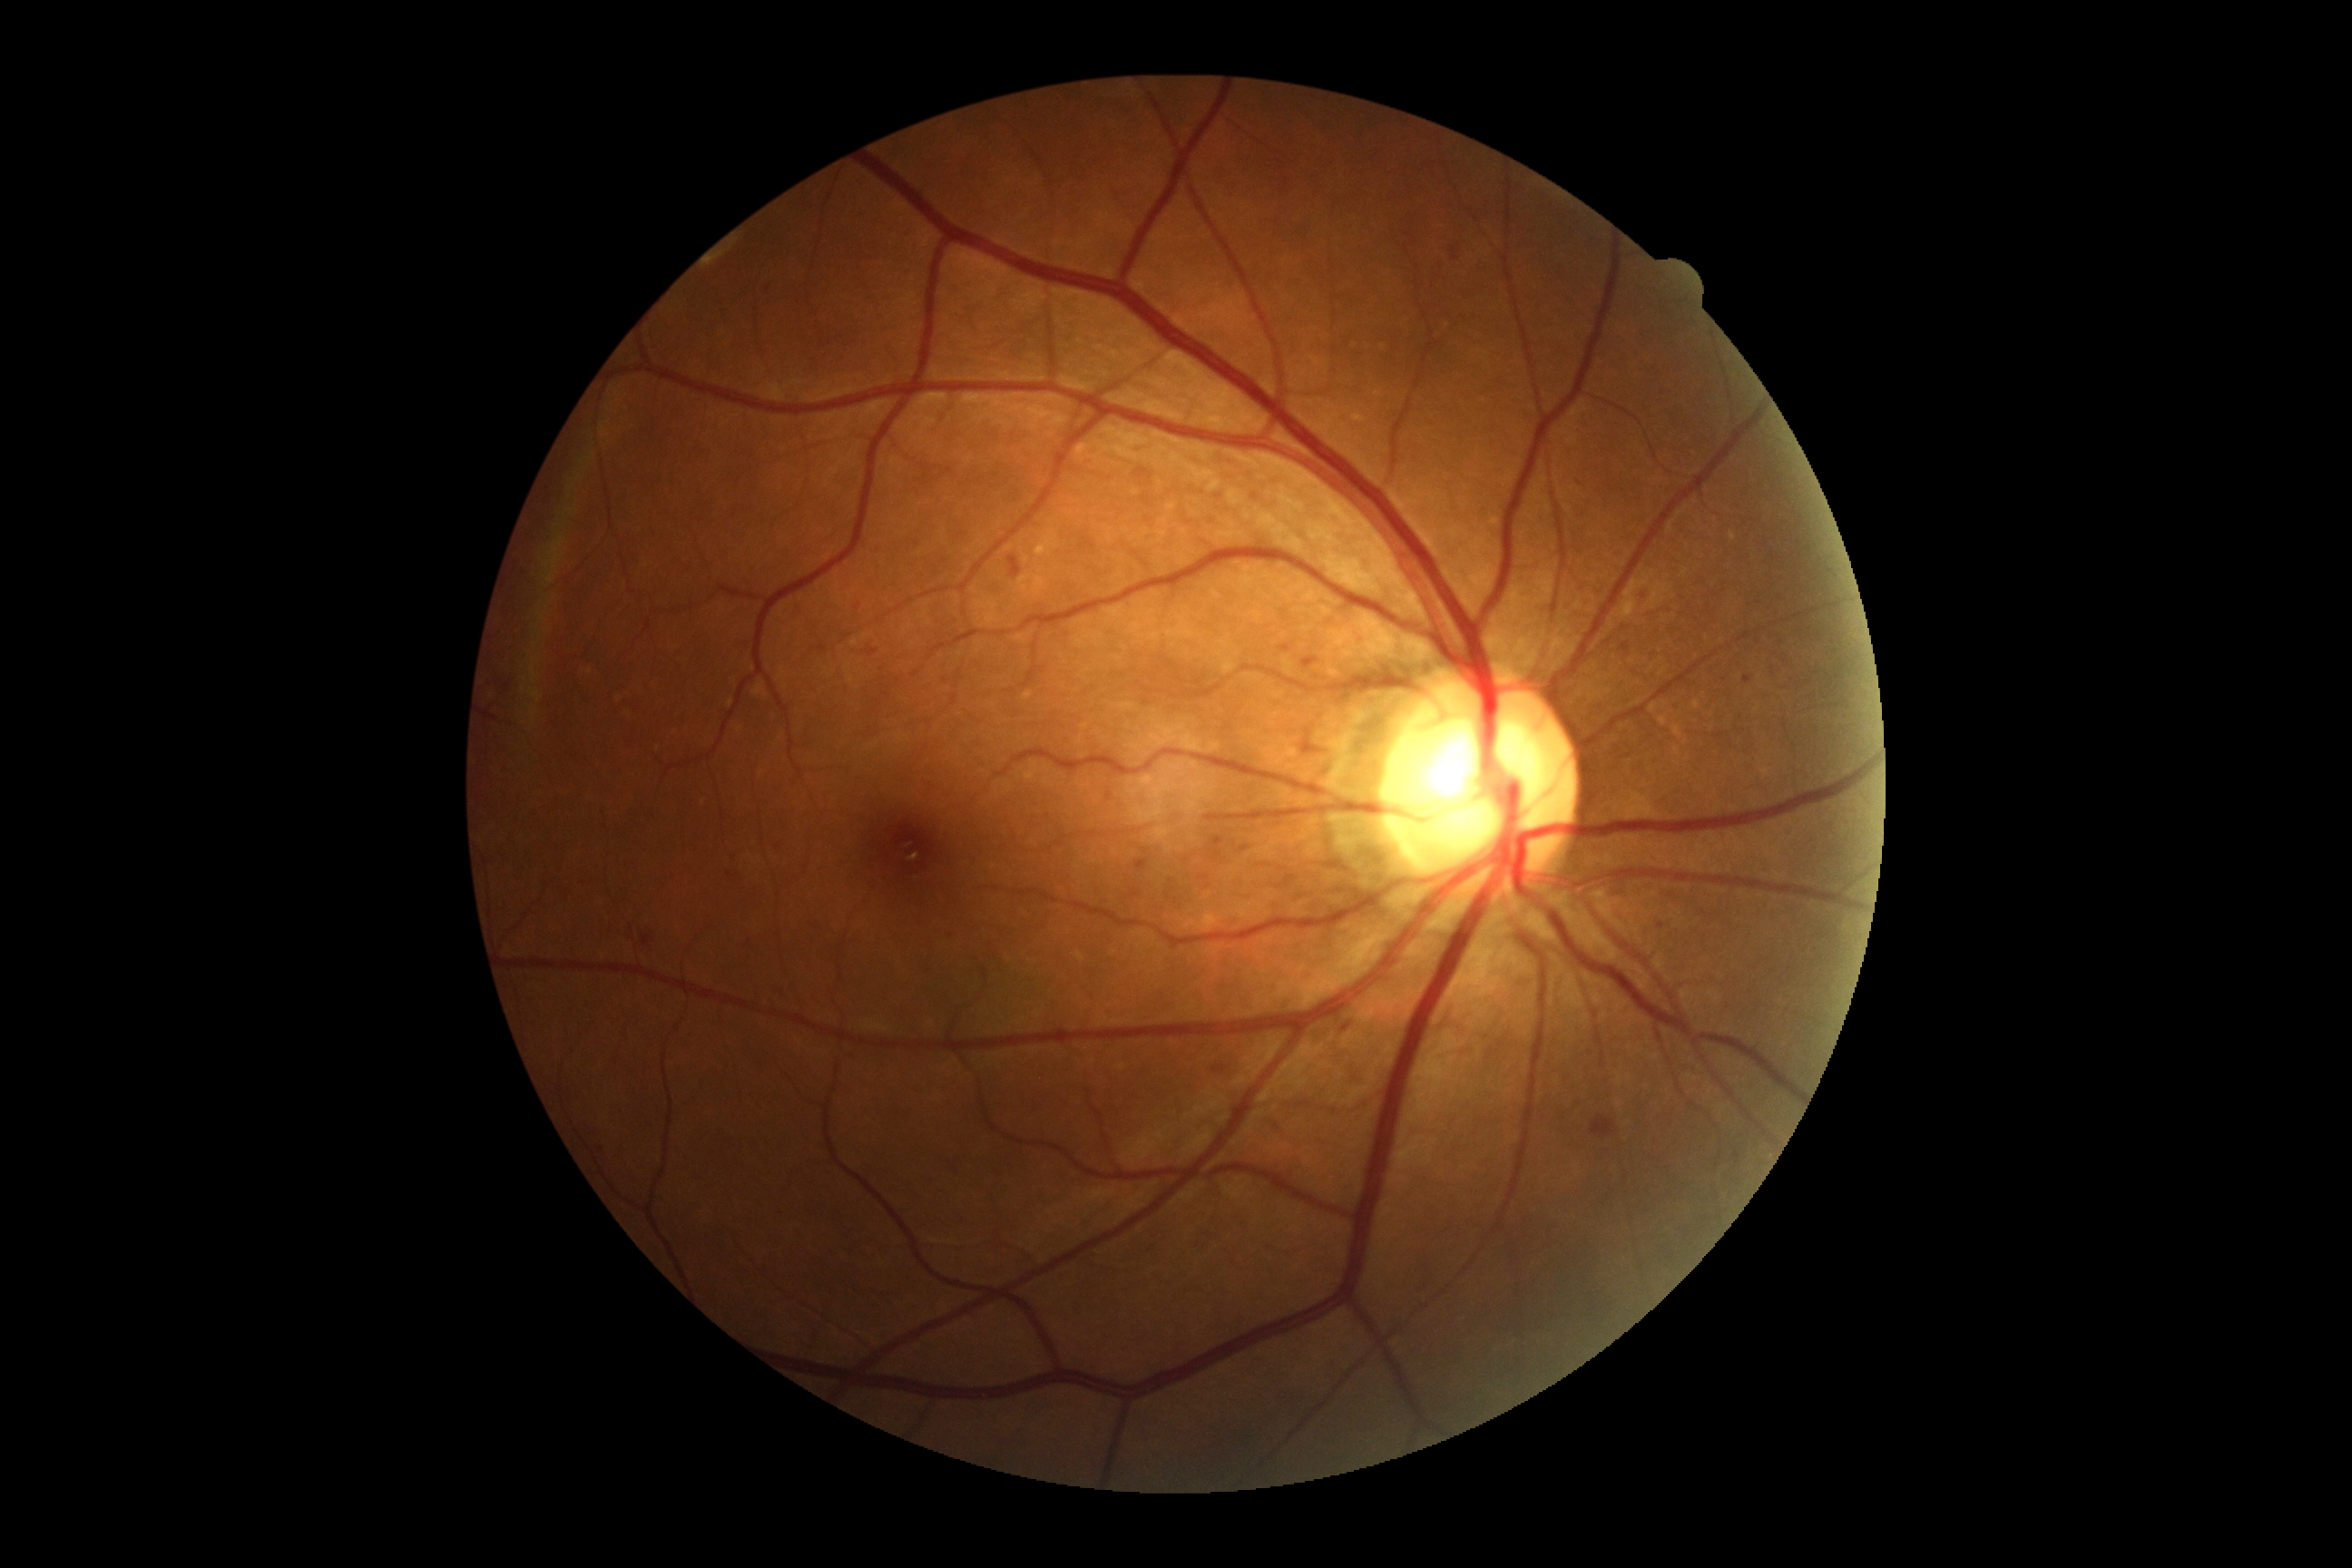
diabetic retinopathy: 2/4.